Image size 2352x1568. FOV: 45 degrees. Color fundus image — 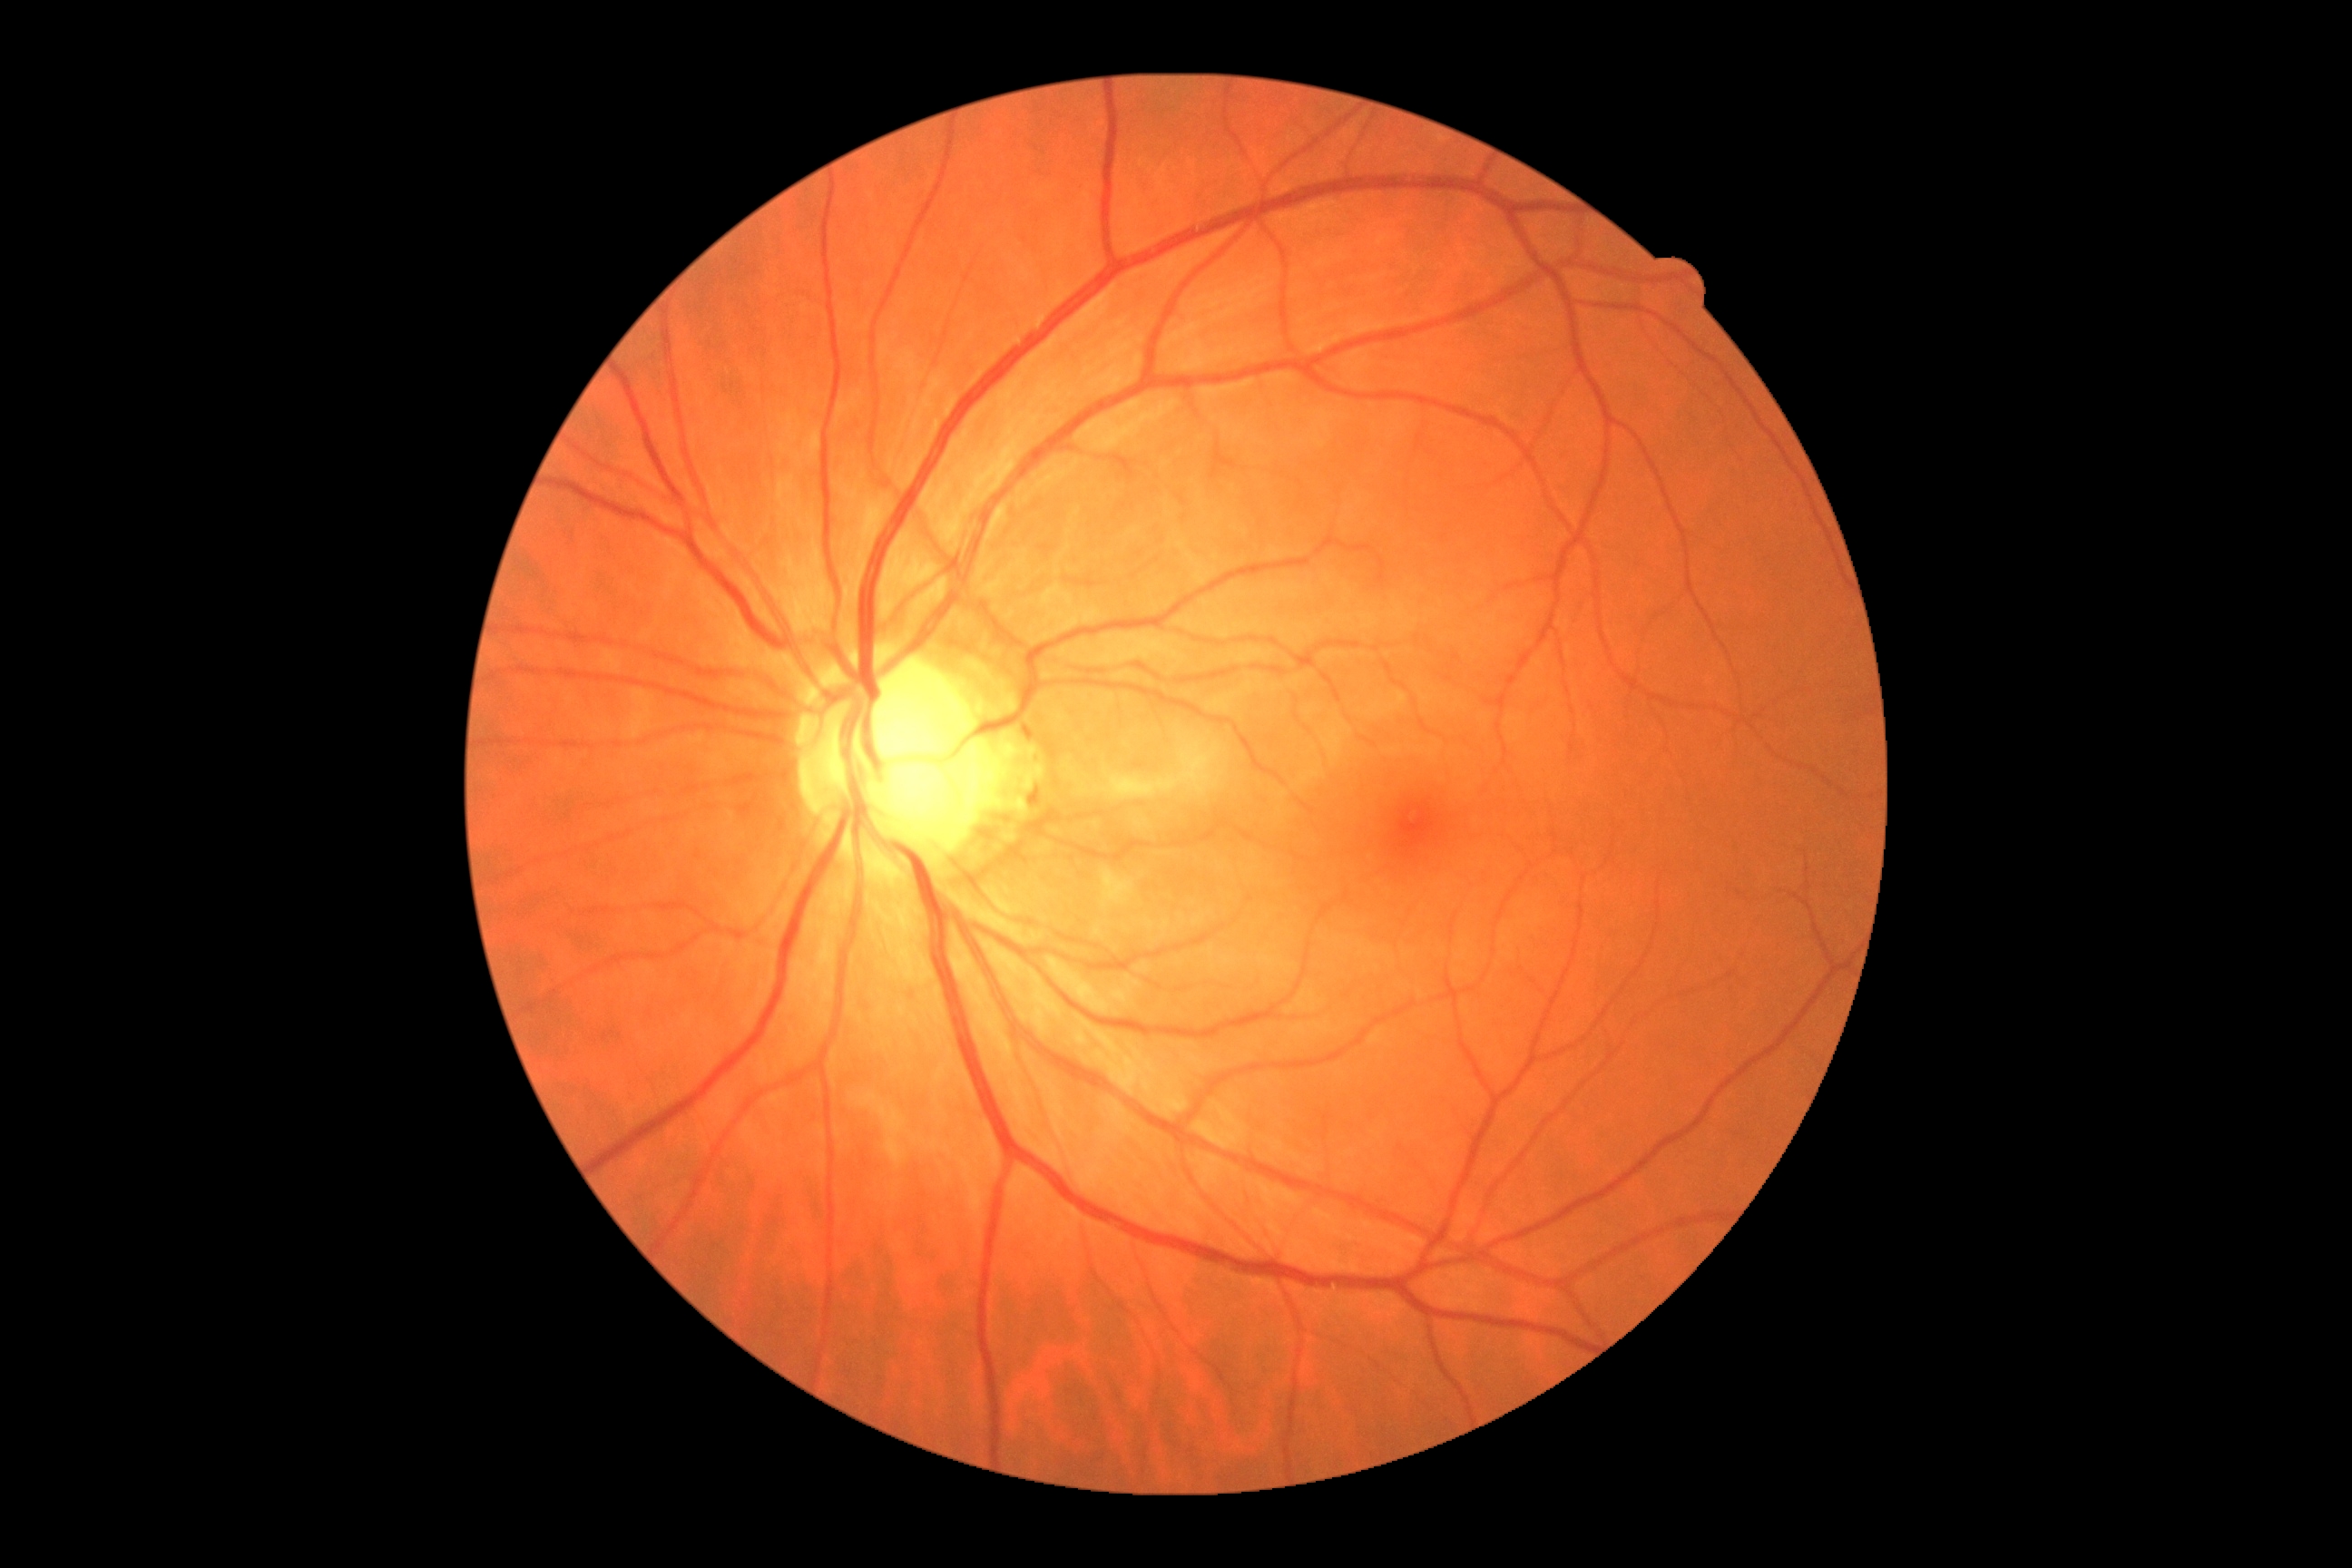 Retinopathy is no apparent retinopathy (grade 0).